RetCam wide-field infant fundus image · captured with the Clarity RetCam 3 (130° field of view):
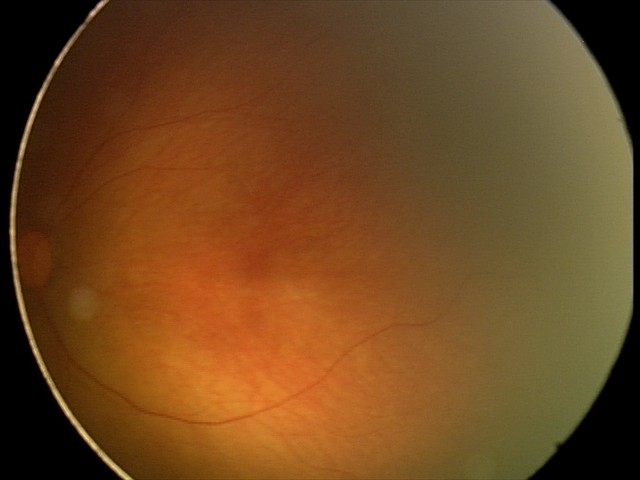

Normal screening examination.